NIDEK AFC-230; 45 degree fundus photograph: 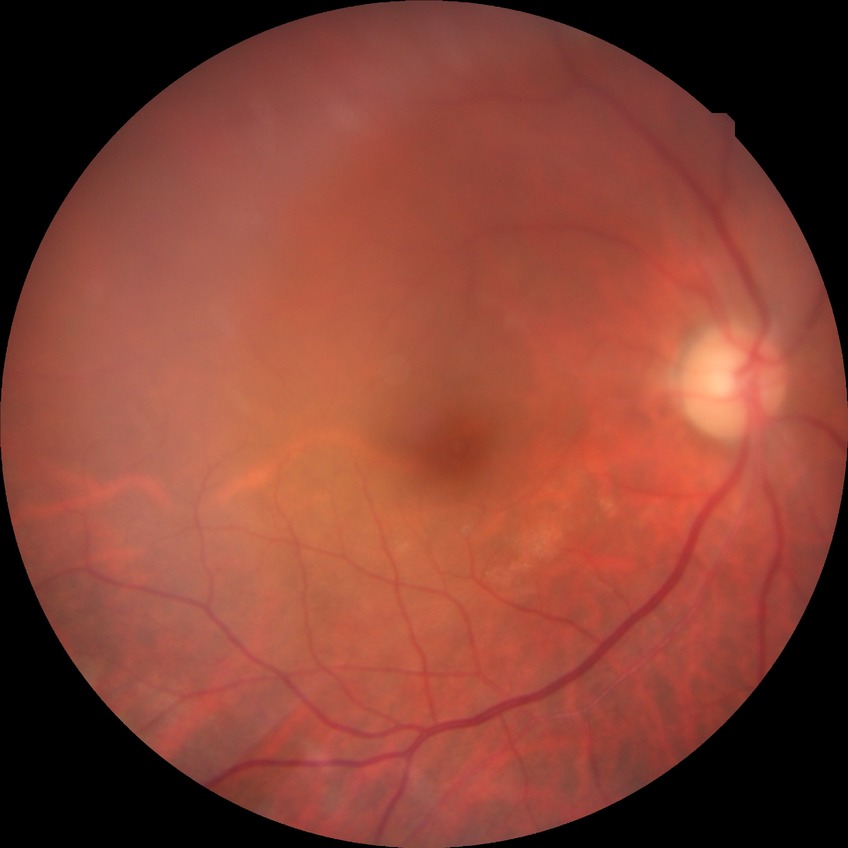

Diabetic retinopathy severity: no diabetic retinopathy.